Pediatric retinal photograph (wide-field) · captured with the Phoenix ICON (100° field of view)
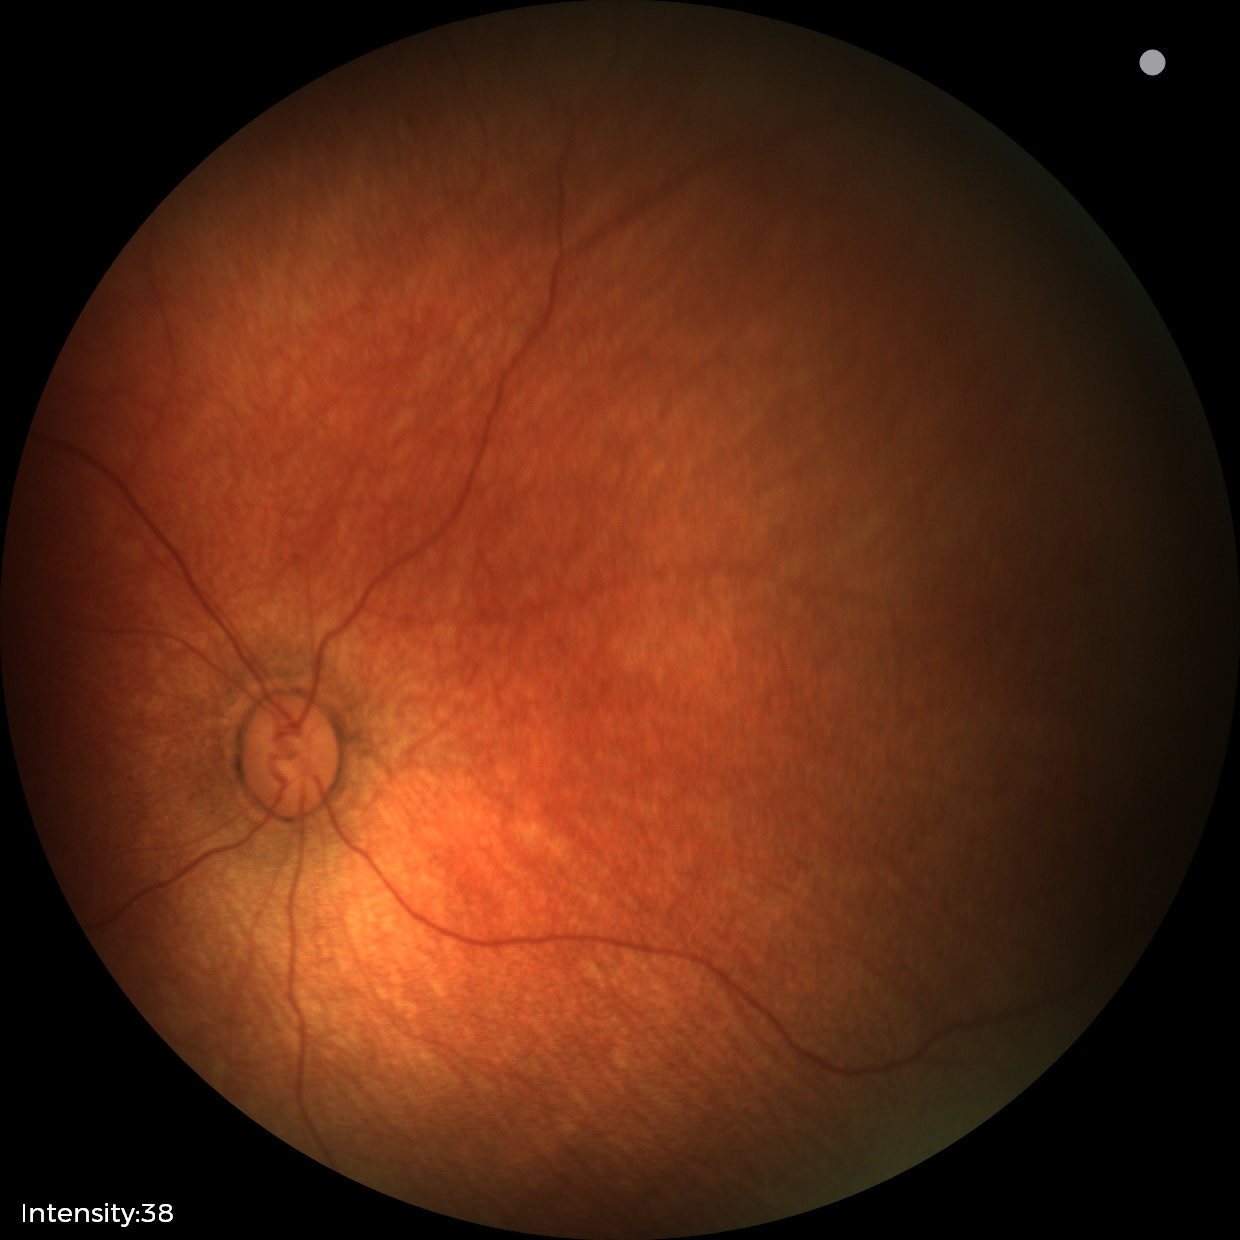
Assessment: physiological finding.